1240 by 1240 pixels; wide-field fundus photograph from neonatal ROP screening
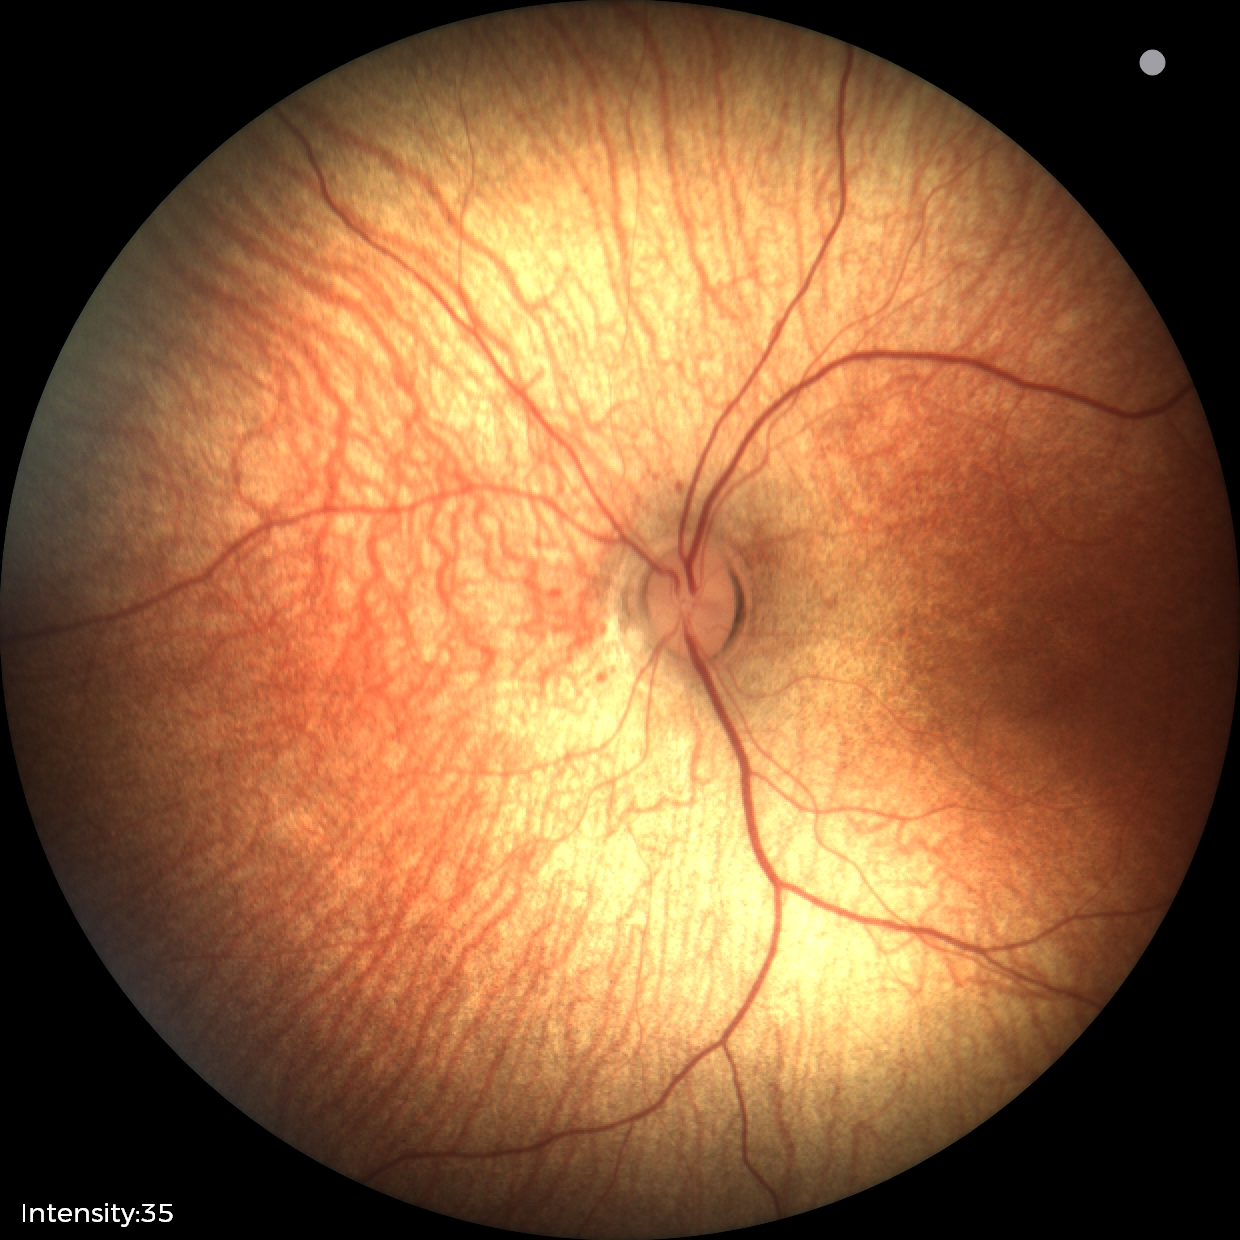
Examination with physiological retinal findings.